Wide-field fundus photograph of an infant:
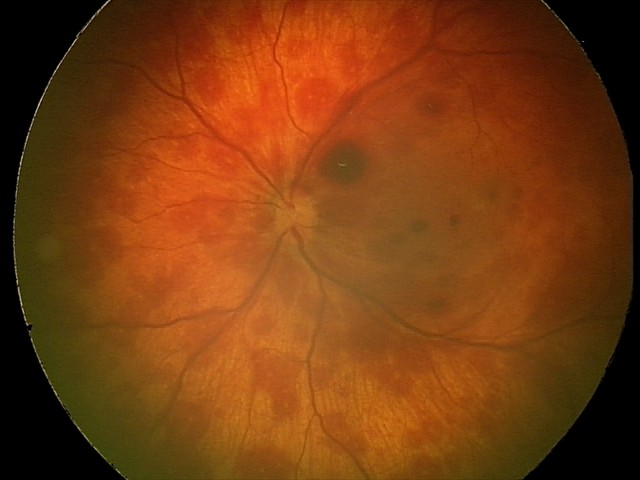

Diagnosis from this screening exam: retinal hemorrhages.